Color fundus photograph: 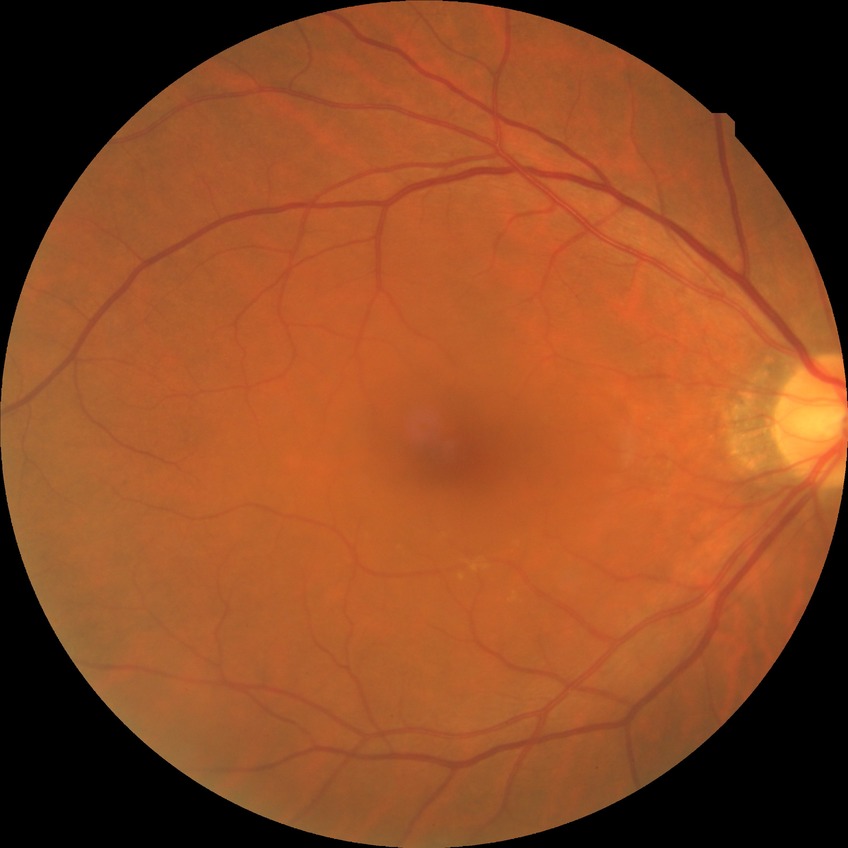 diabetic retinopathy (DR) = no diabetic retinopathy (NDR).